1659x2212px · acquired with a Remidio smartphone fundus camera · retinal fundus photograph — 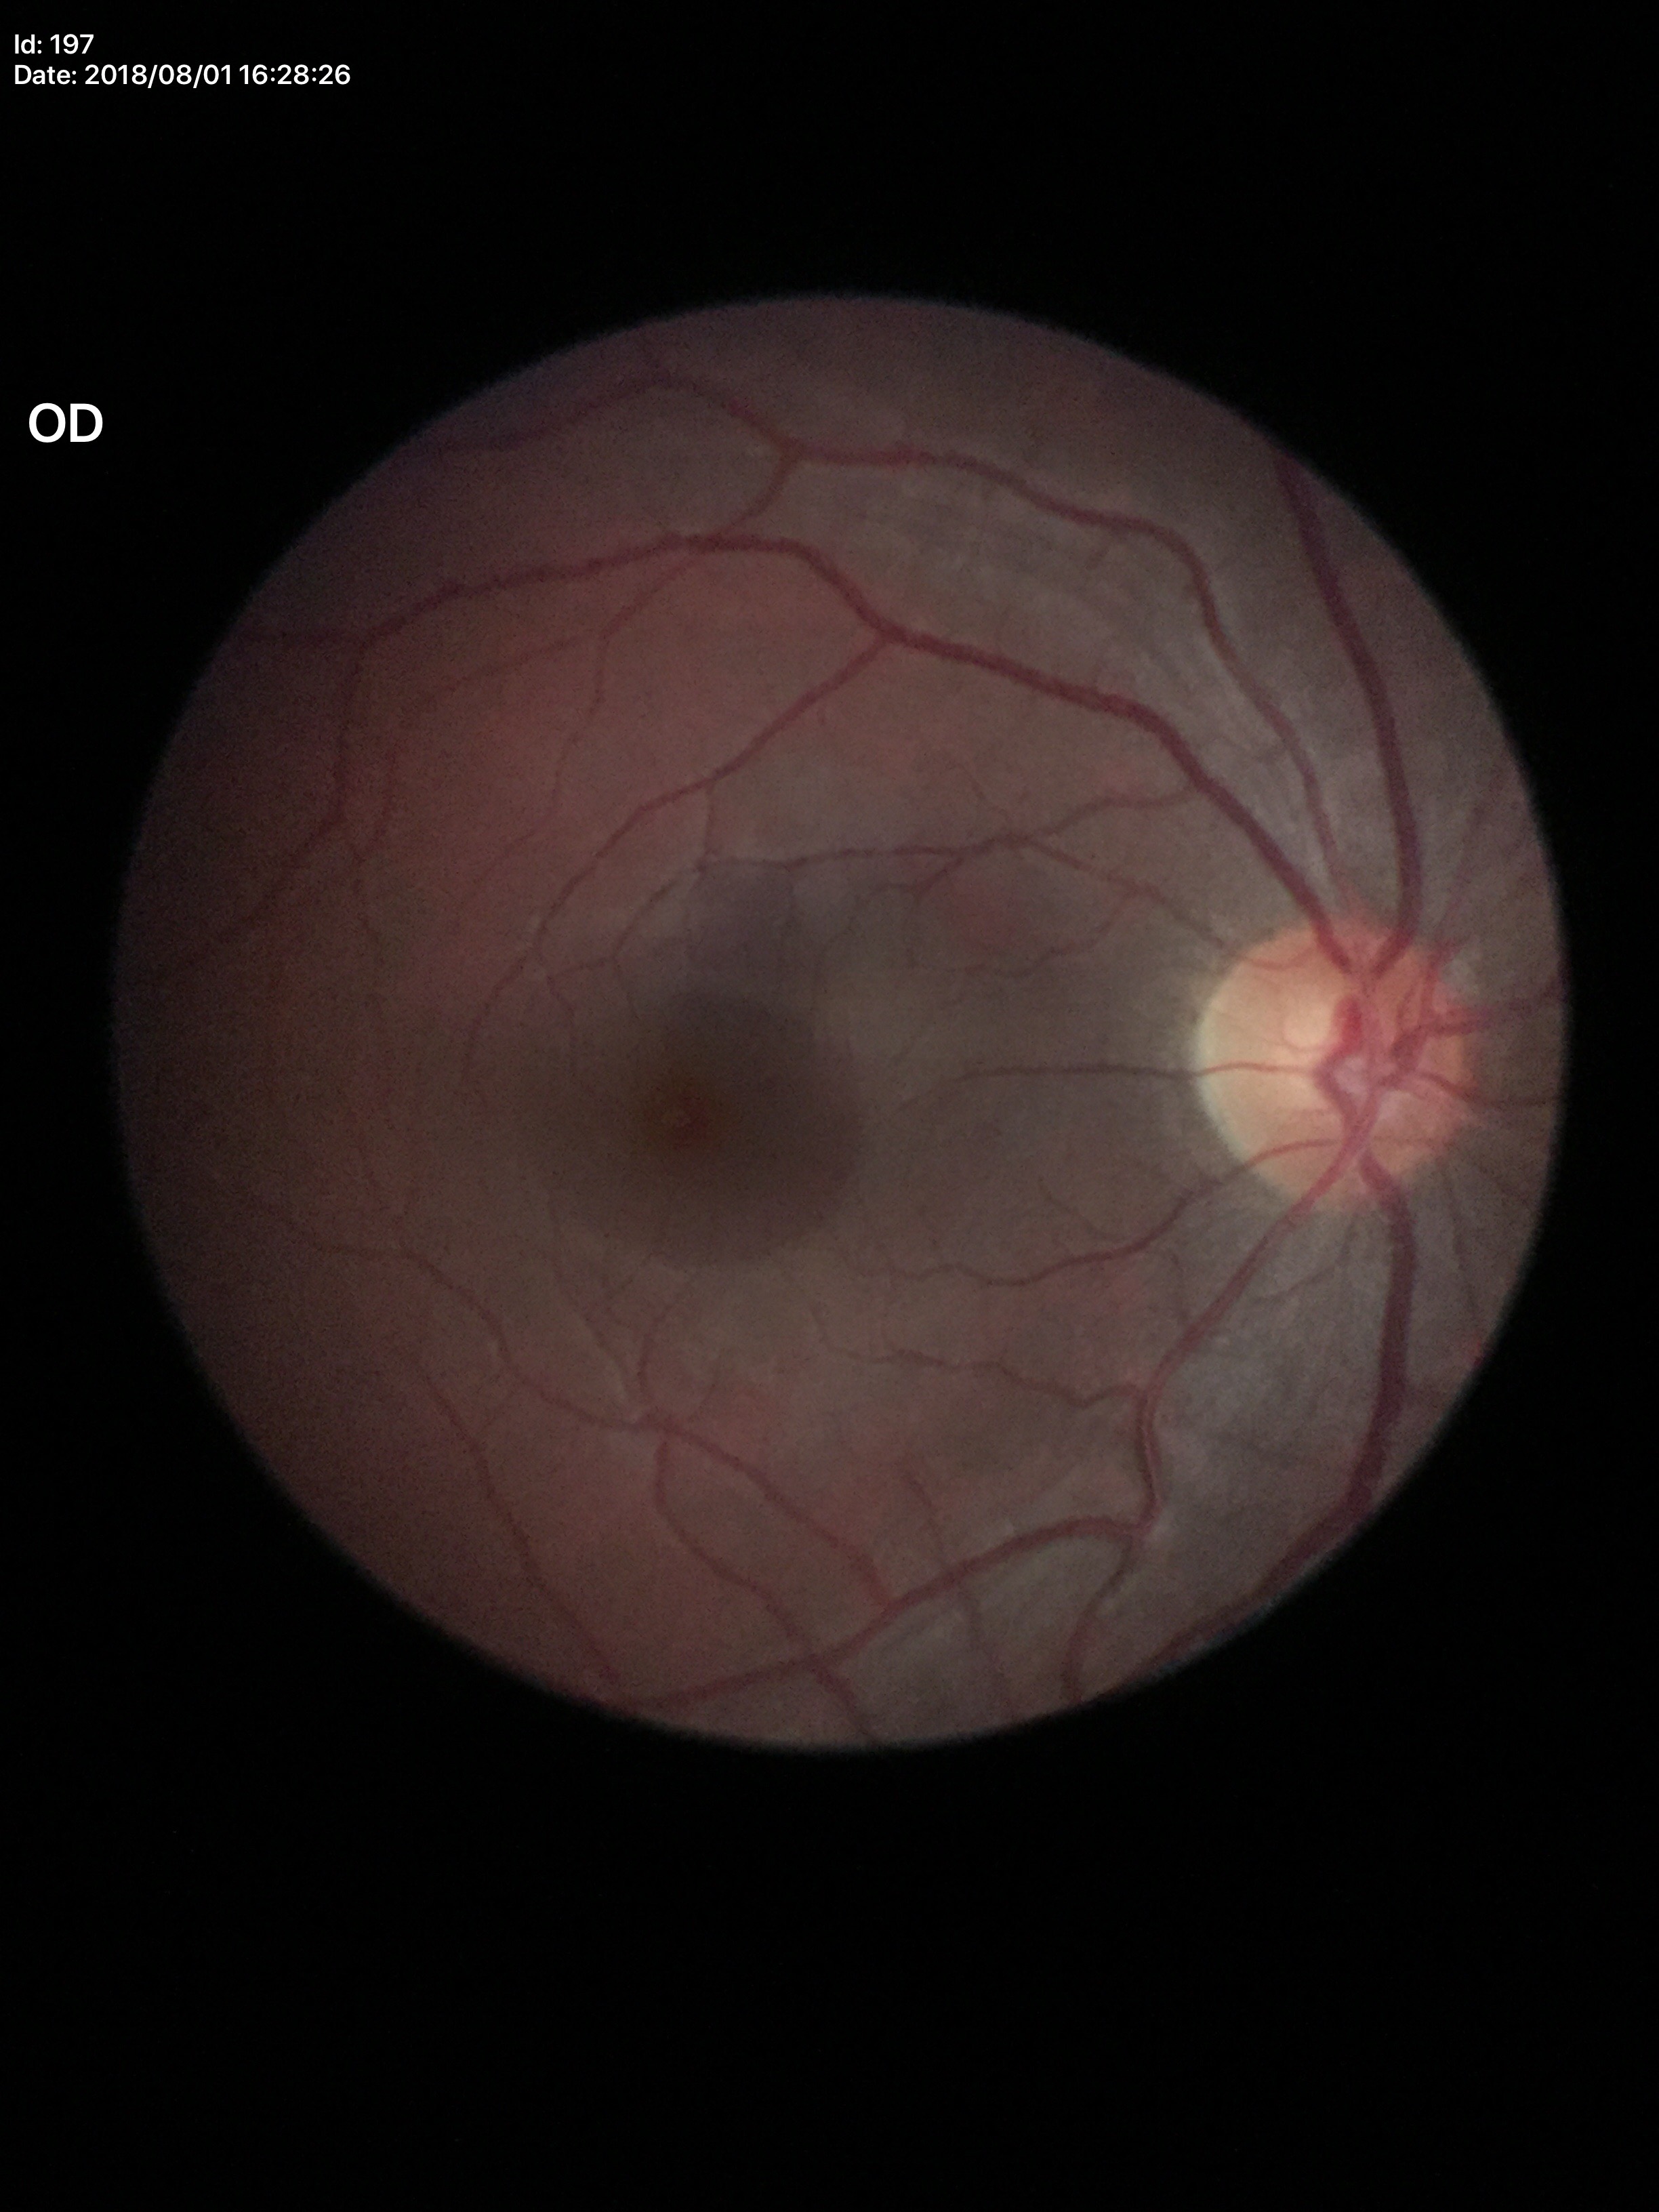
No evidence of glaucoma (1/5 graders called glaucoma suspect).
Vertical C/D ratio of 0.54.
Horizontal cup-to-disc ratio is 0.54.